Retinal fundus photograph:
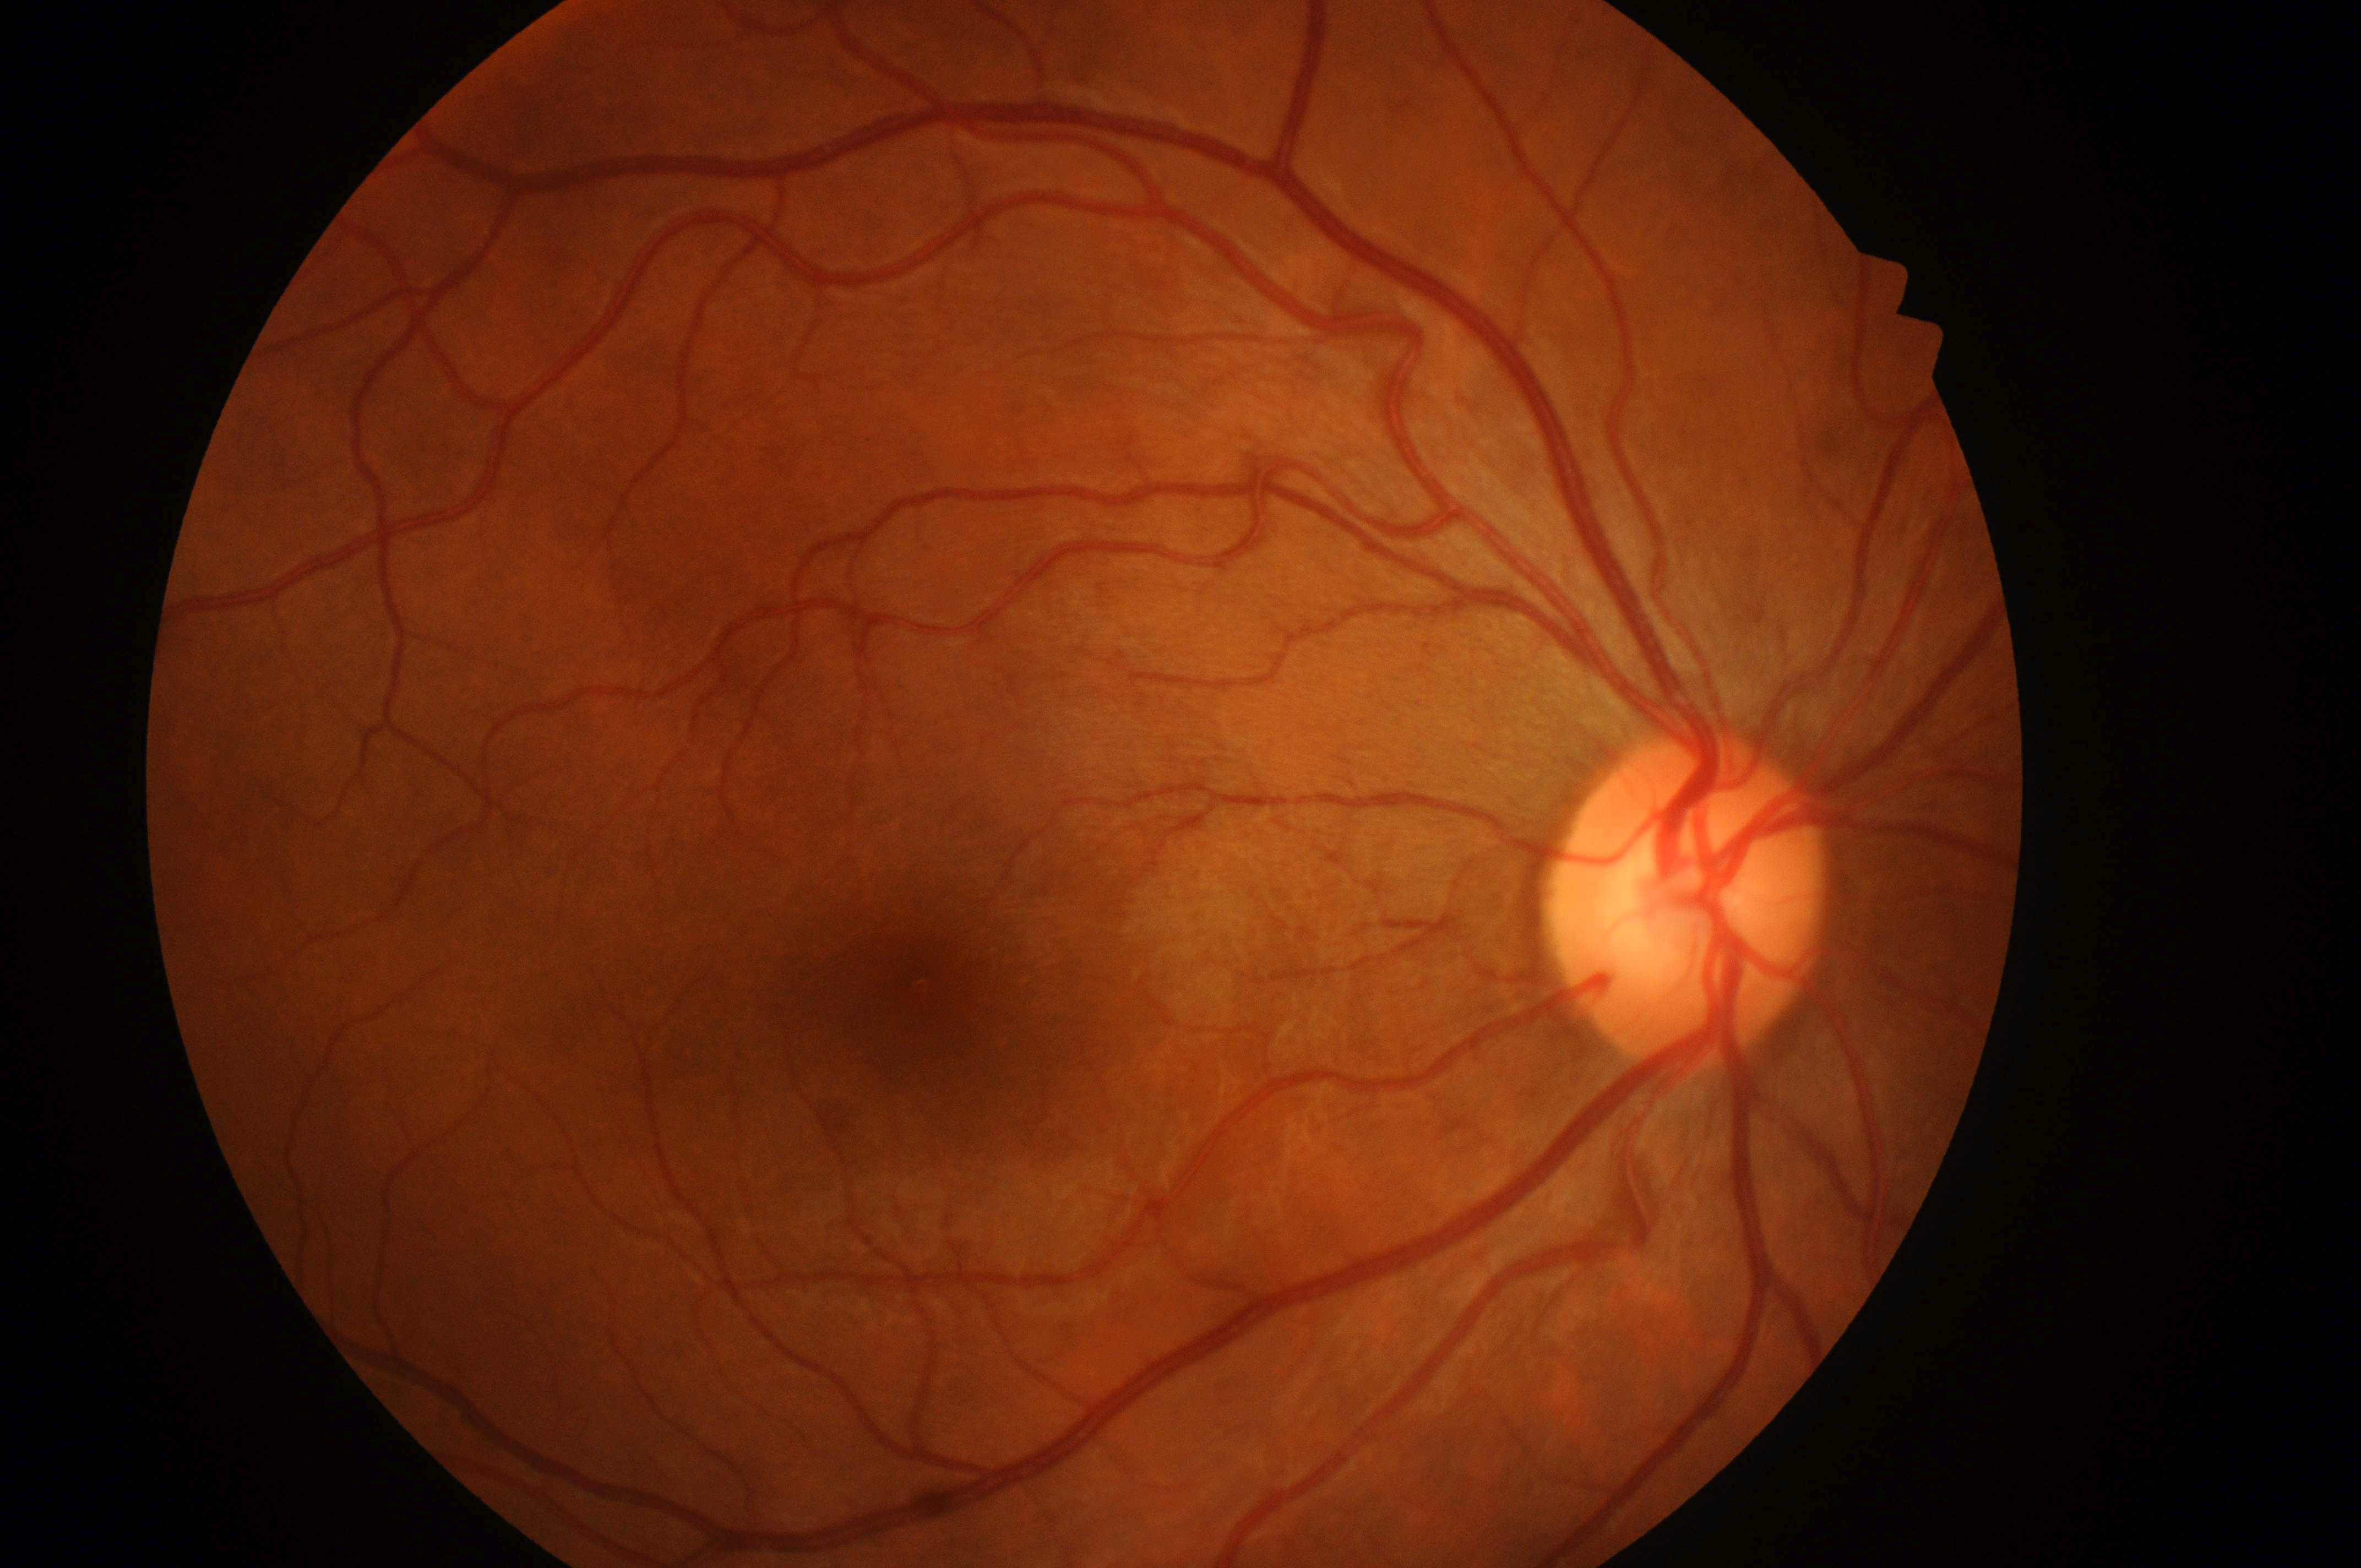

No DR or DME findings
diabetic macular edema (DME): no risk (grade 0)
right eye
diabetic retinopathy (DR): no apparent diabetic retinopathy (grade 0)
the fovea: 918, 1022
optic disc center: 1683, 919